Cropped from a 35-degree field of view; optic disc-centered crop from a color fundus photograph:
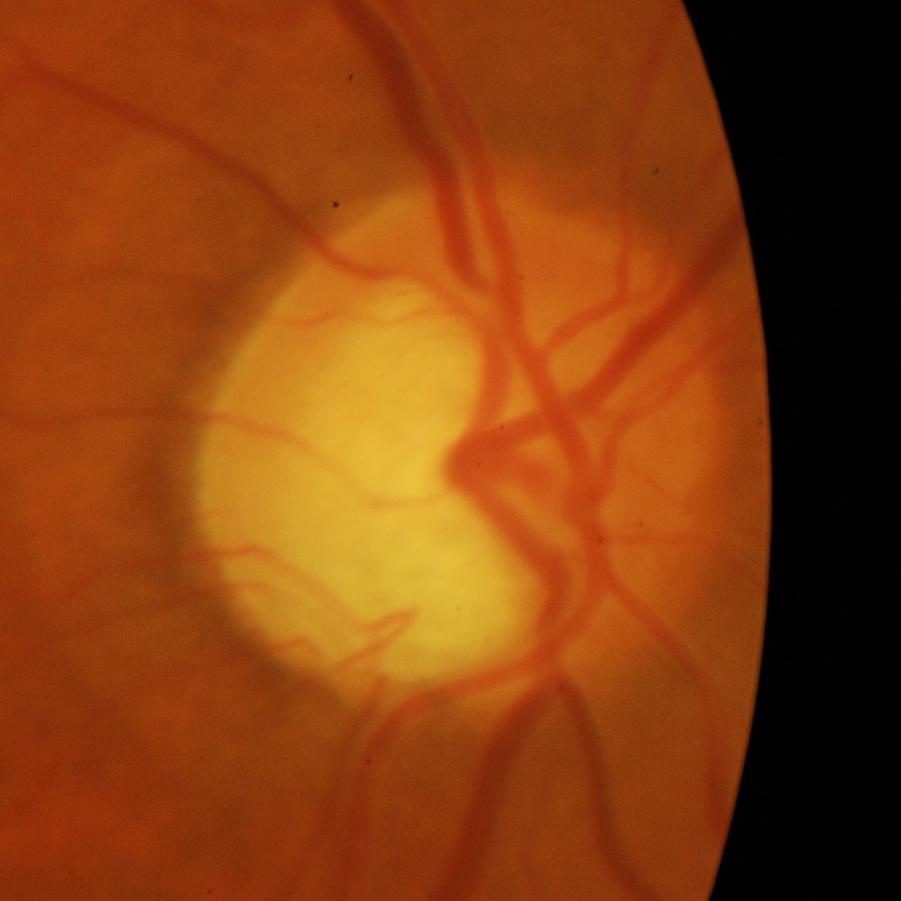

Optic disc appearance consistent with evidence of glaucoma.